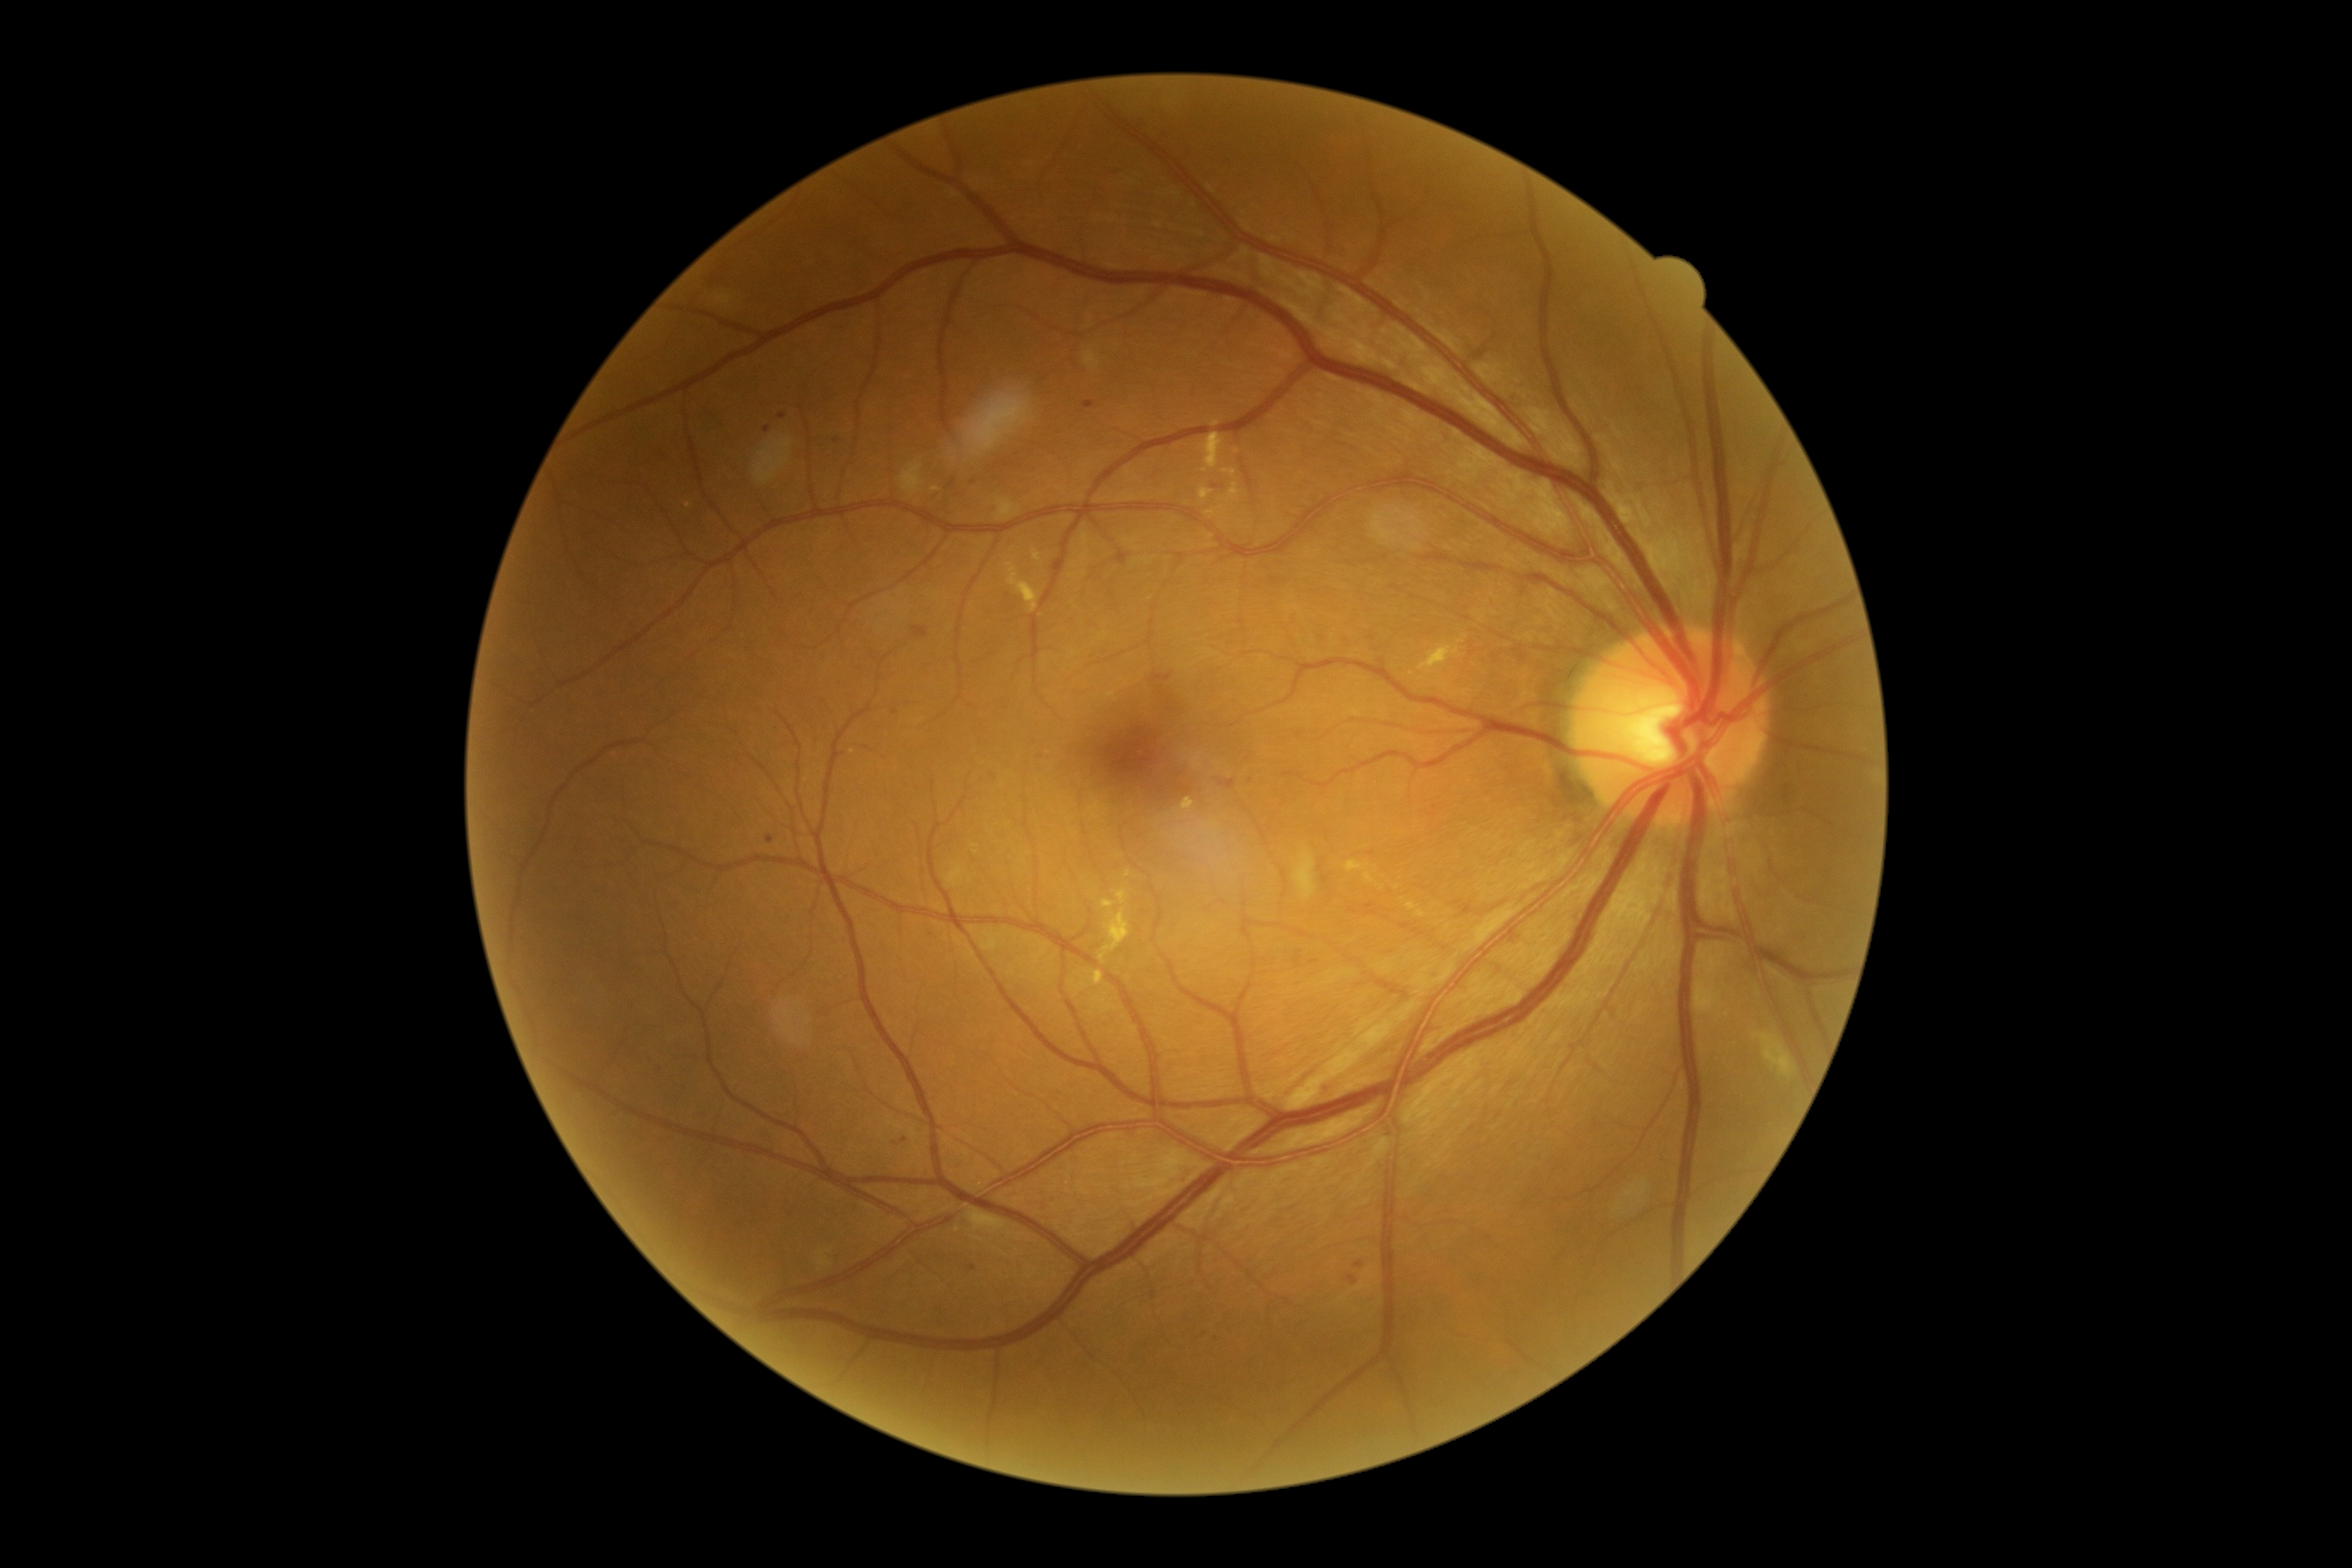 Diabetic retinopathy (DR) is grade 2 (moderate NPDR)
Representative lesions:
hard exudates (EXs) (partial): {"x1": 1005, "y1": 563, "x2": 1039, "y2": 613}, {"x1": 1199, "y1": 489, "x2": 1213, "y2": 501}, {"x1": 1227, "y1": 482, "x2": 1240, "y2": 505}, {"x1": 1364, "y1": 873, "x2": 1375, "y2": 885}, {"x1": 1407, "y1": 902, "x2": 1418, "y2": 910}, {"x1": 1108, "y1": 692, "x2": 1117, "y2": 699}, {"x1": 1182, "y1": 797, "x2": 1196, "y2": 814}, {"x1": 1204, "y1": 434, "x2": 1225, "y2": 470}
Small EXs approximately at pt(1397, 888), pt(1205, 471), pt(1421, 913)
microaneurysms (MAs) (partial): {"x1": 912, "y1": 627, "x2": 928, "y2": 639}, {"x1": 1295, "y1": 952, "x2": 1302, "y2": 967}, {"x1": 969, "y1": 1265, "x2": 976, "y2": 1273}, {"x1": 948, "y1": 481, "x2": 957, "y2": 489}, {"x1": 778, "y1": 415, "x2": 787, "y2": 420}, {"x1": 1084, "y1": 401, "x2": 1094, "y2": 408}
Small MAs approximately at pt(1251, 781), pt(767, 429), pt(973, 483), pt(1371, 854), pt(1182, 790)